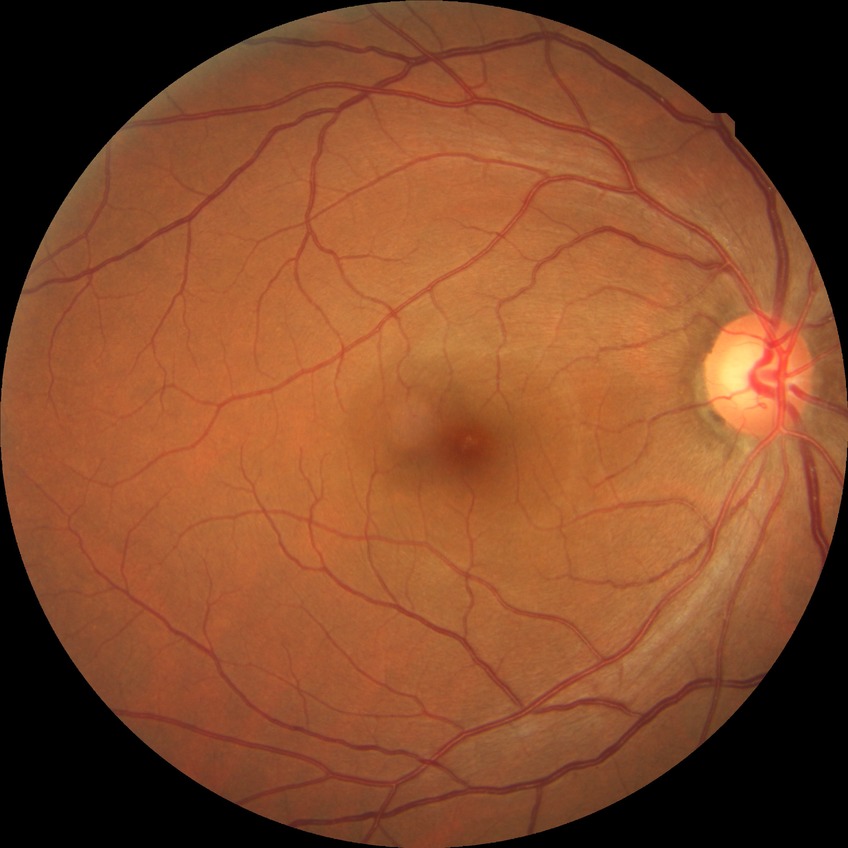

Modified Davis classification is no diabetic retinopathy.